Pediatric wide-field fundus photograph. 640x480px:
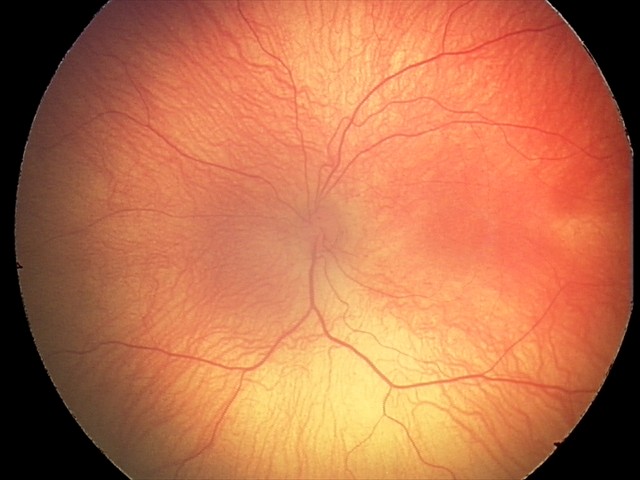

Examination diagnosed as retinopathy of prematurity (ROP) stage 2.